2352 by 1568 pixels, 45° FOV.
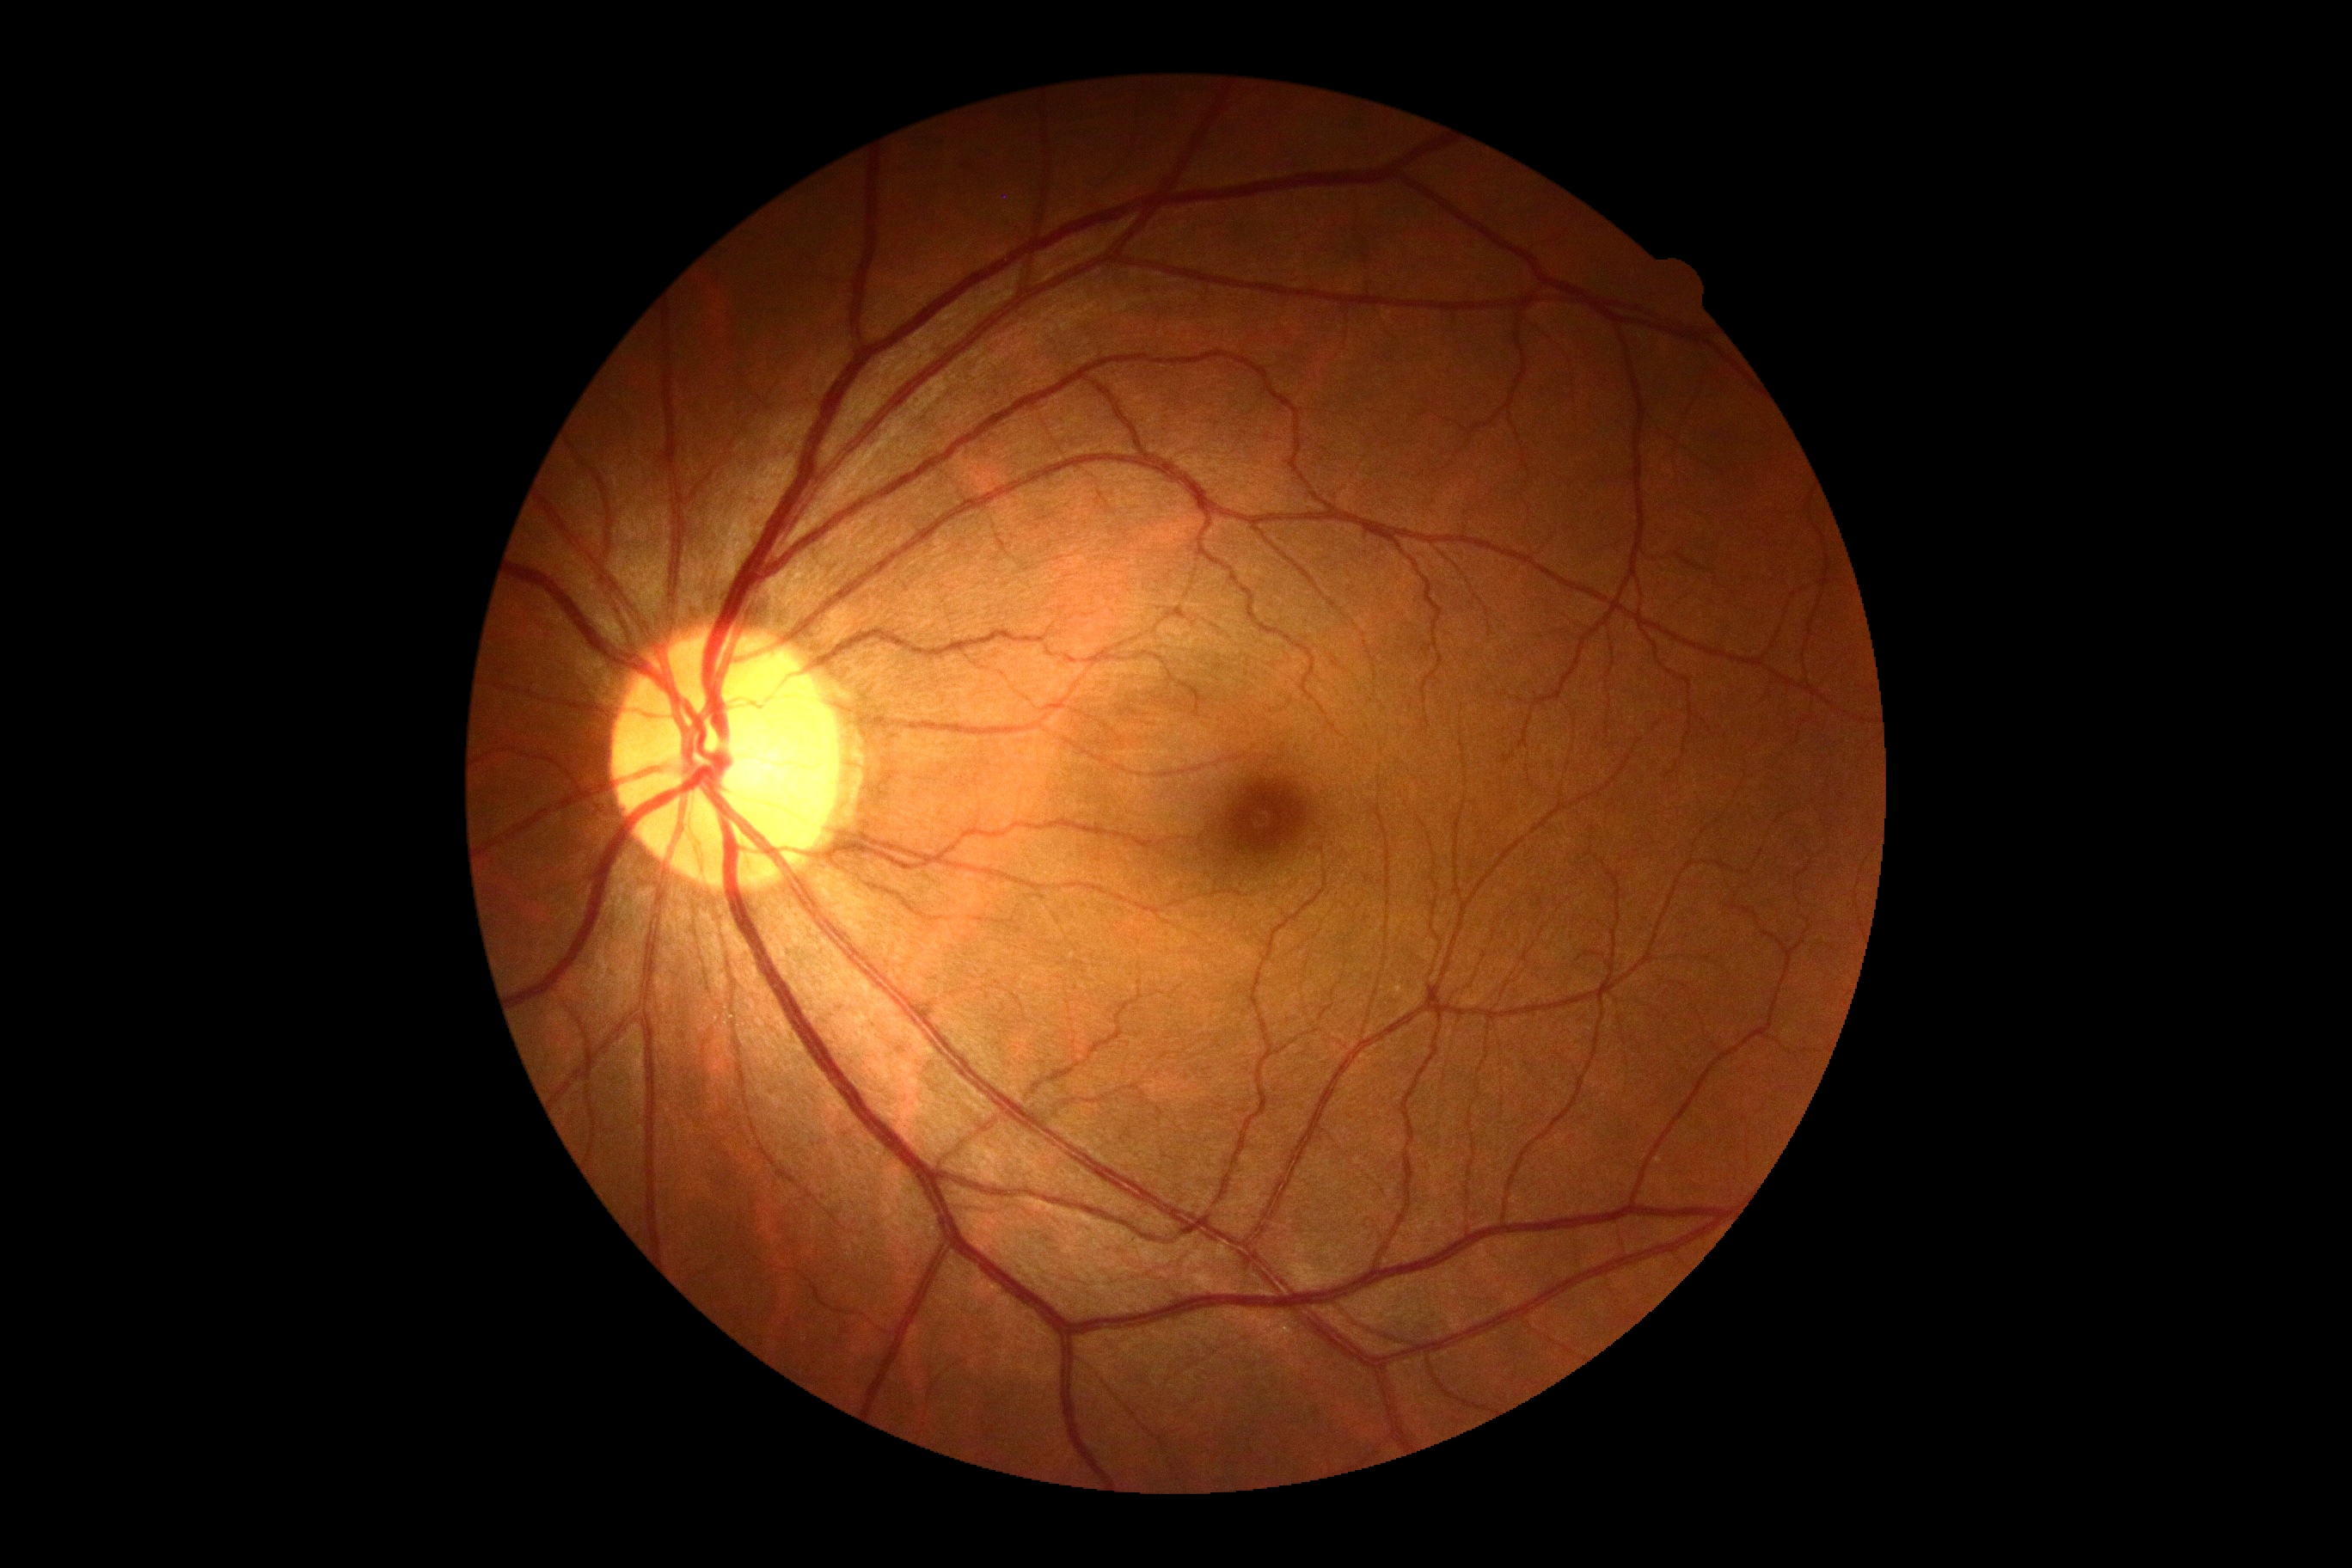
DR stage: grade 0 (no apparent retinopathy) — no visible signs of diabetic retinopathy.